45° field of view:
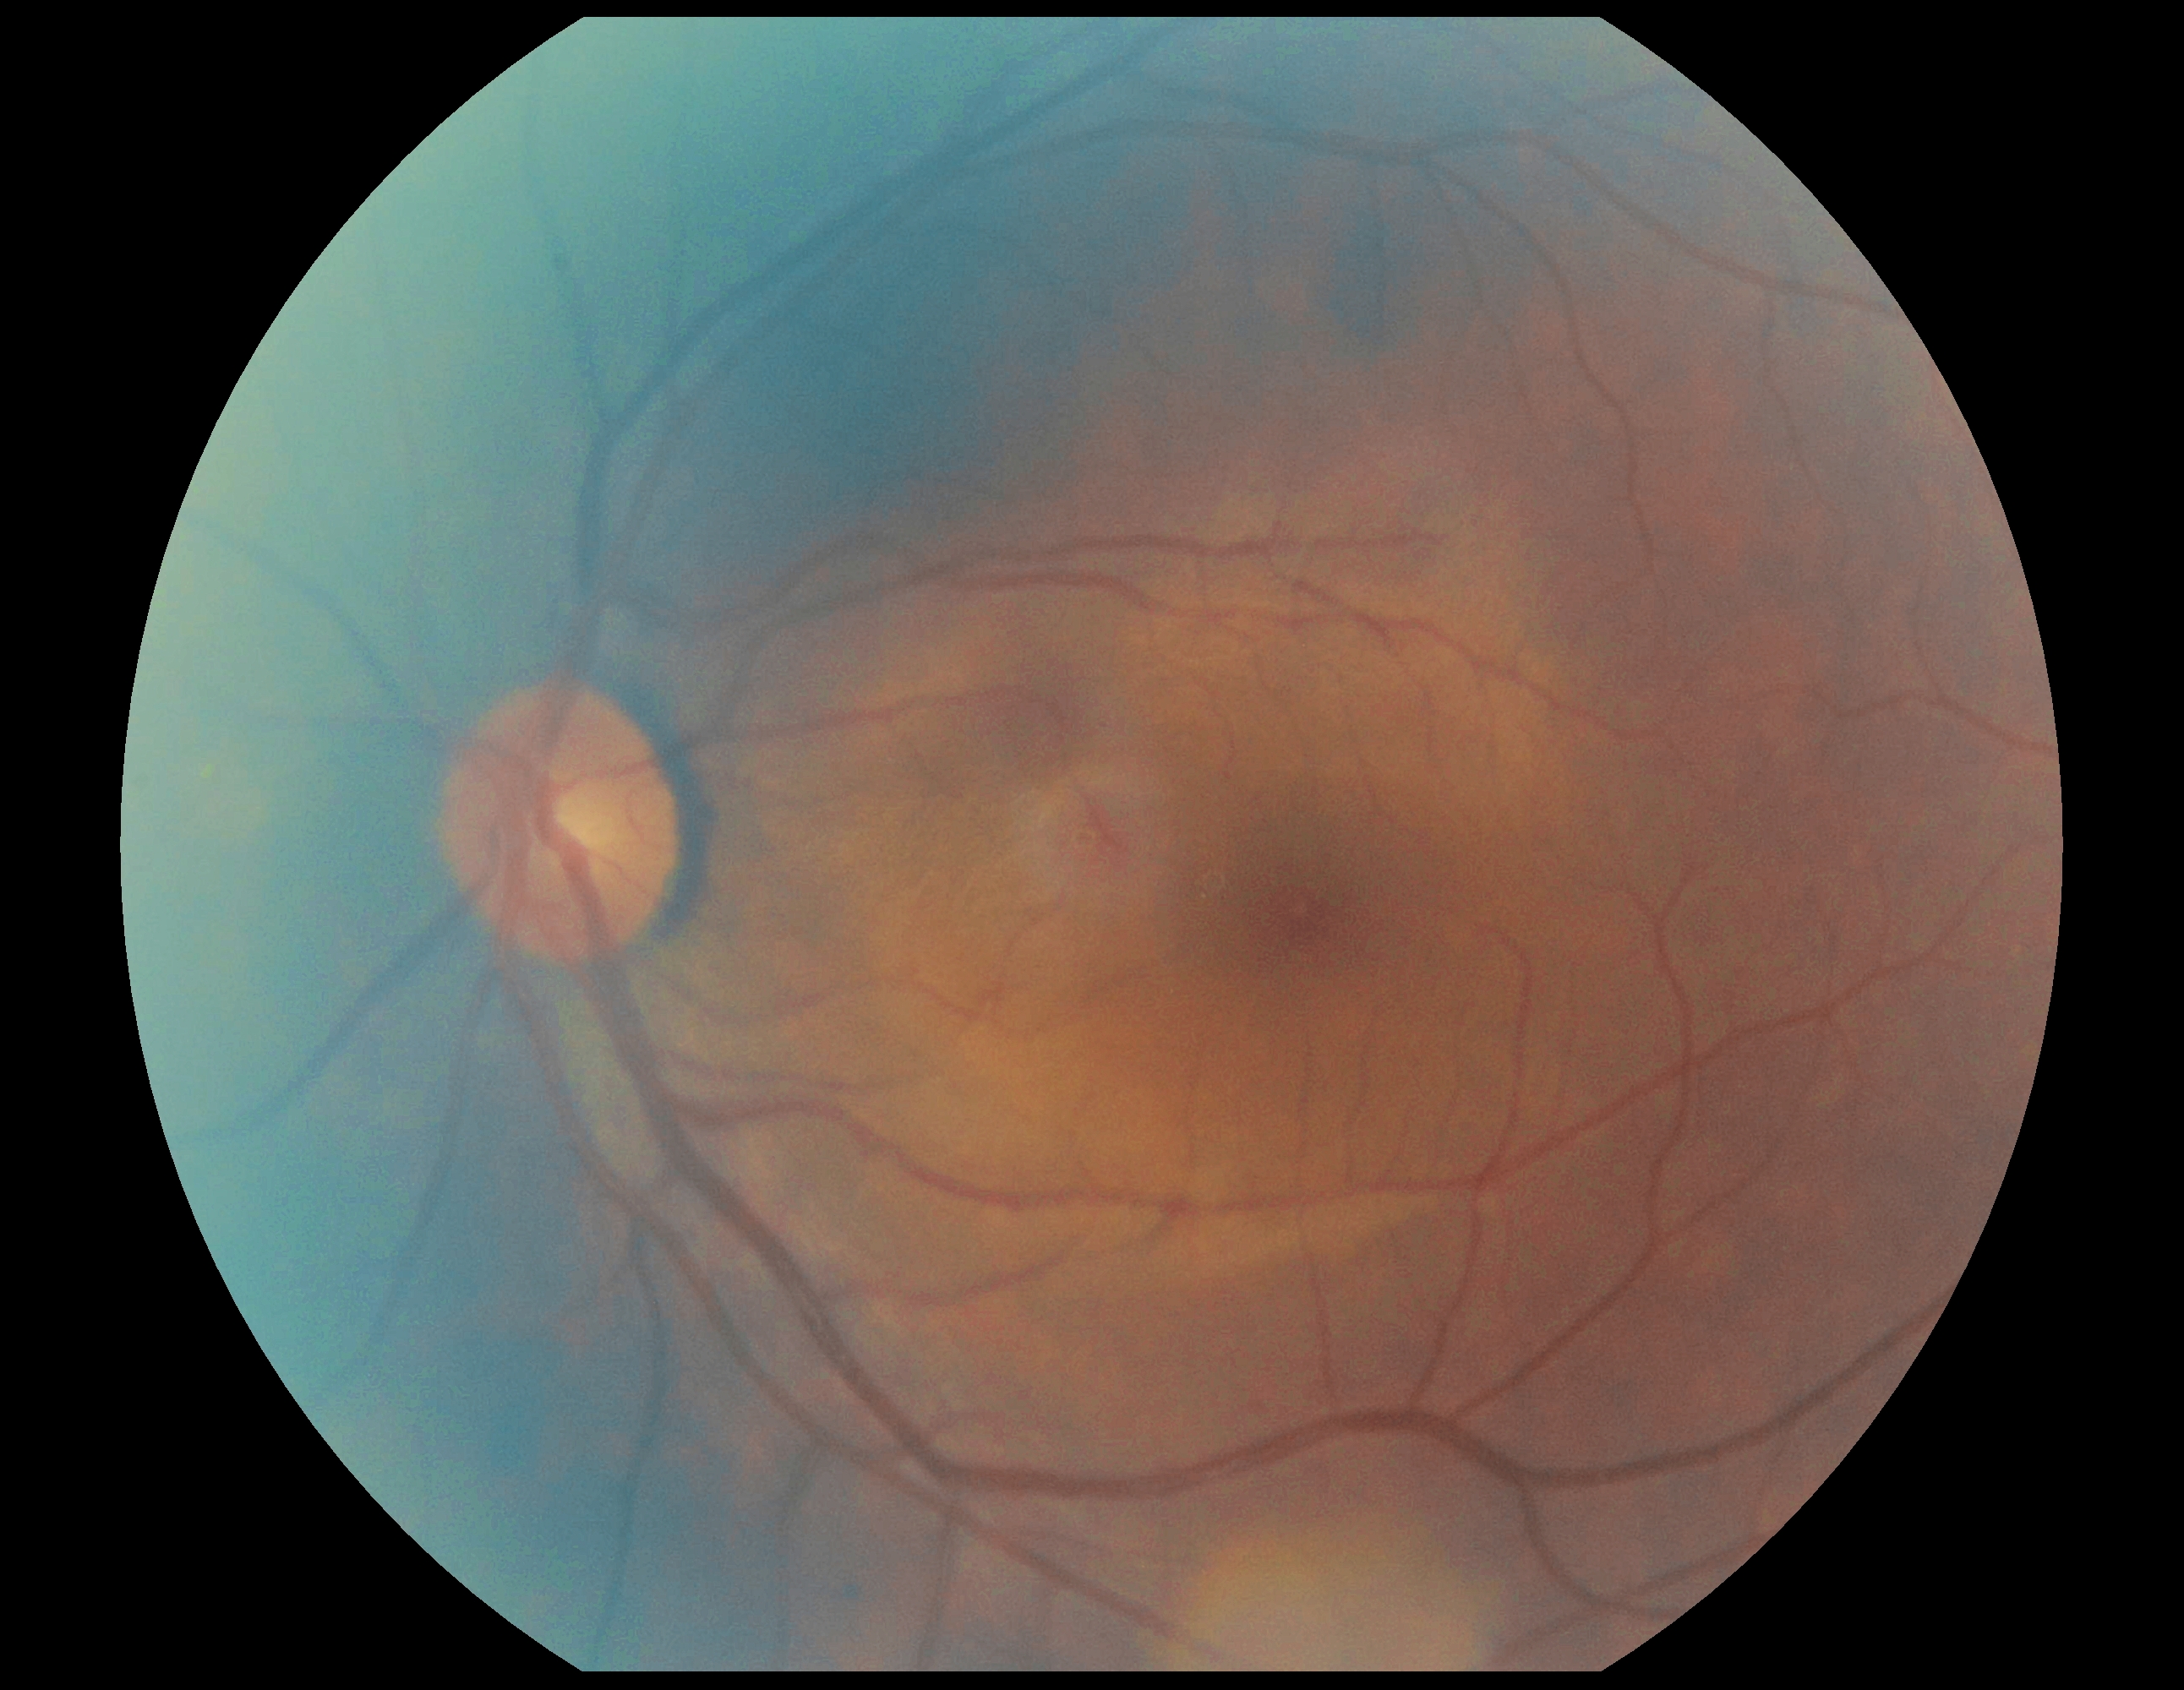
Diabetic retinopathy severity is no apparent retinopathy (grade 0) — no visible signs of diabetic retinopathy.